2352 by 1568 pixels
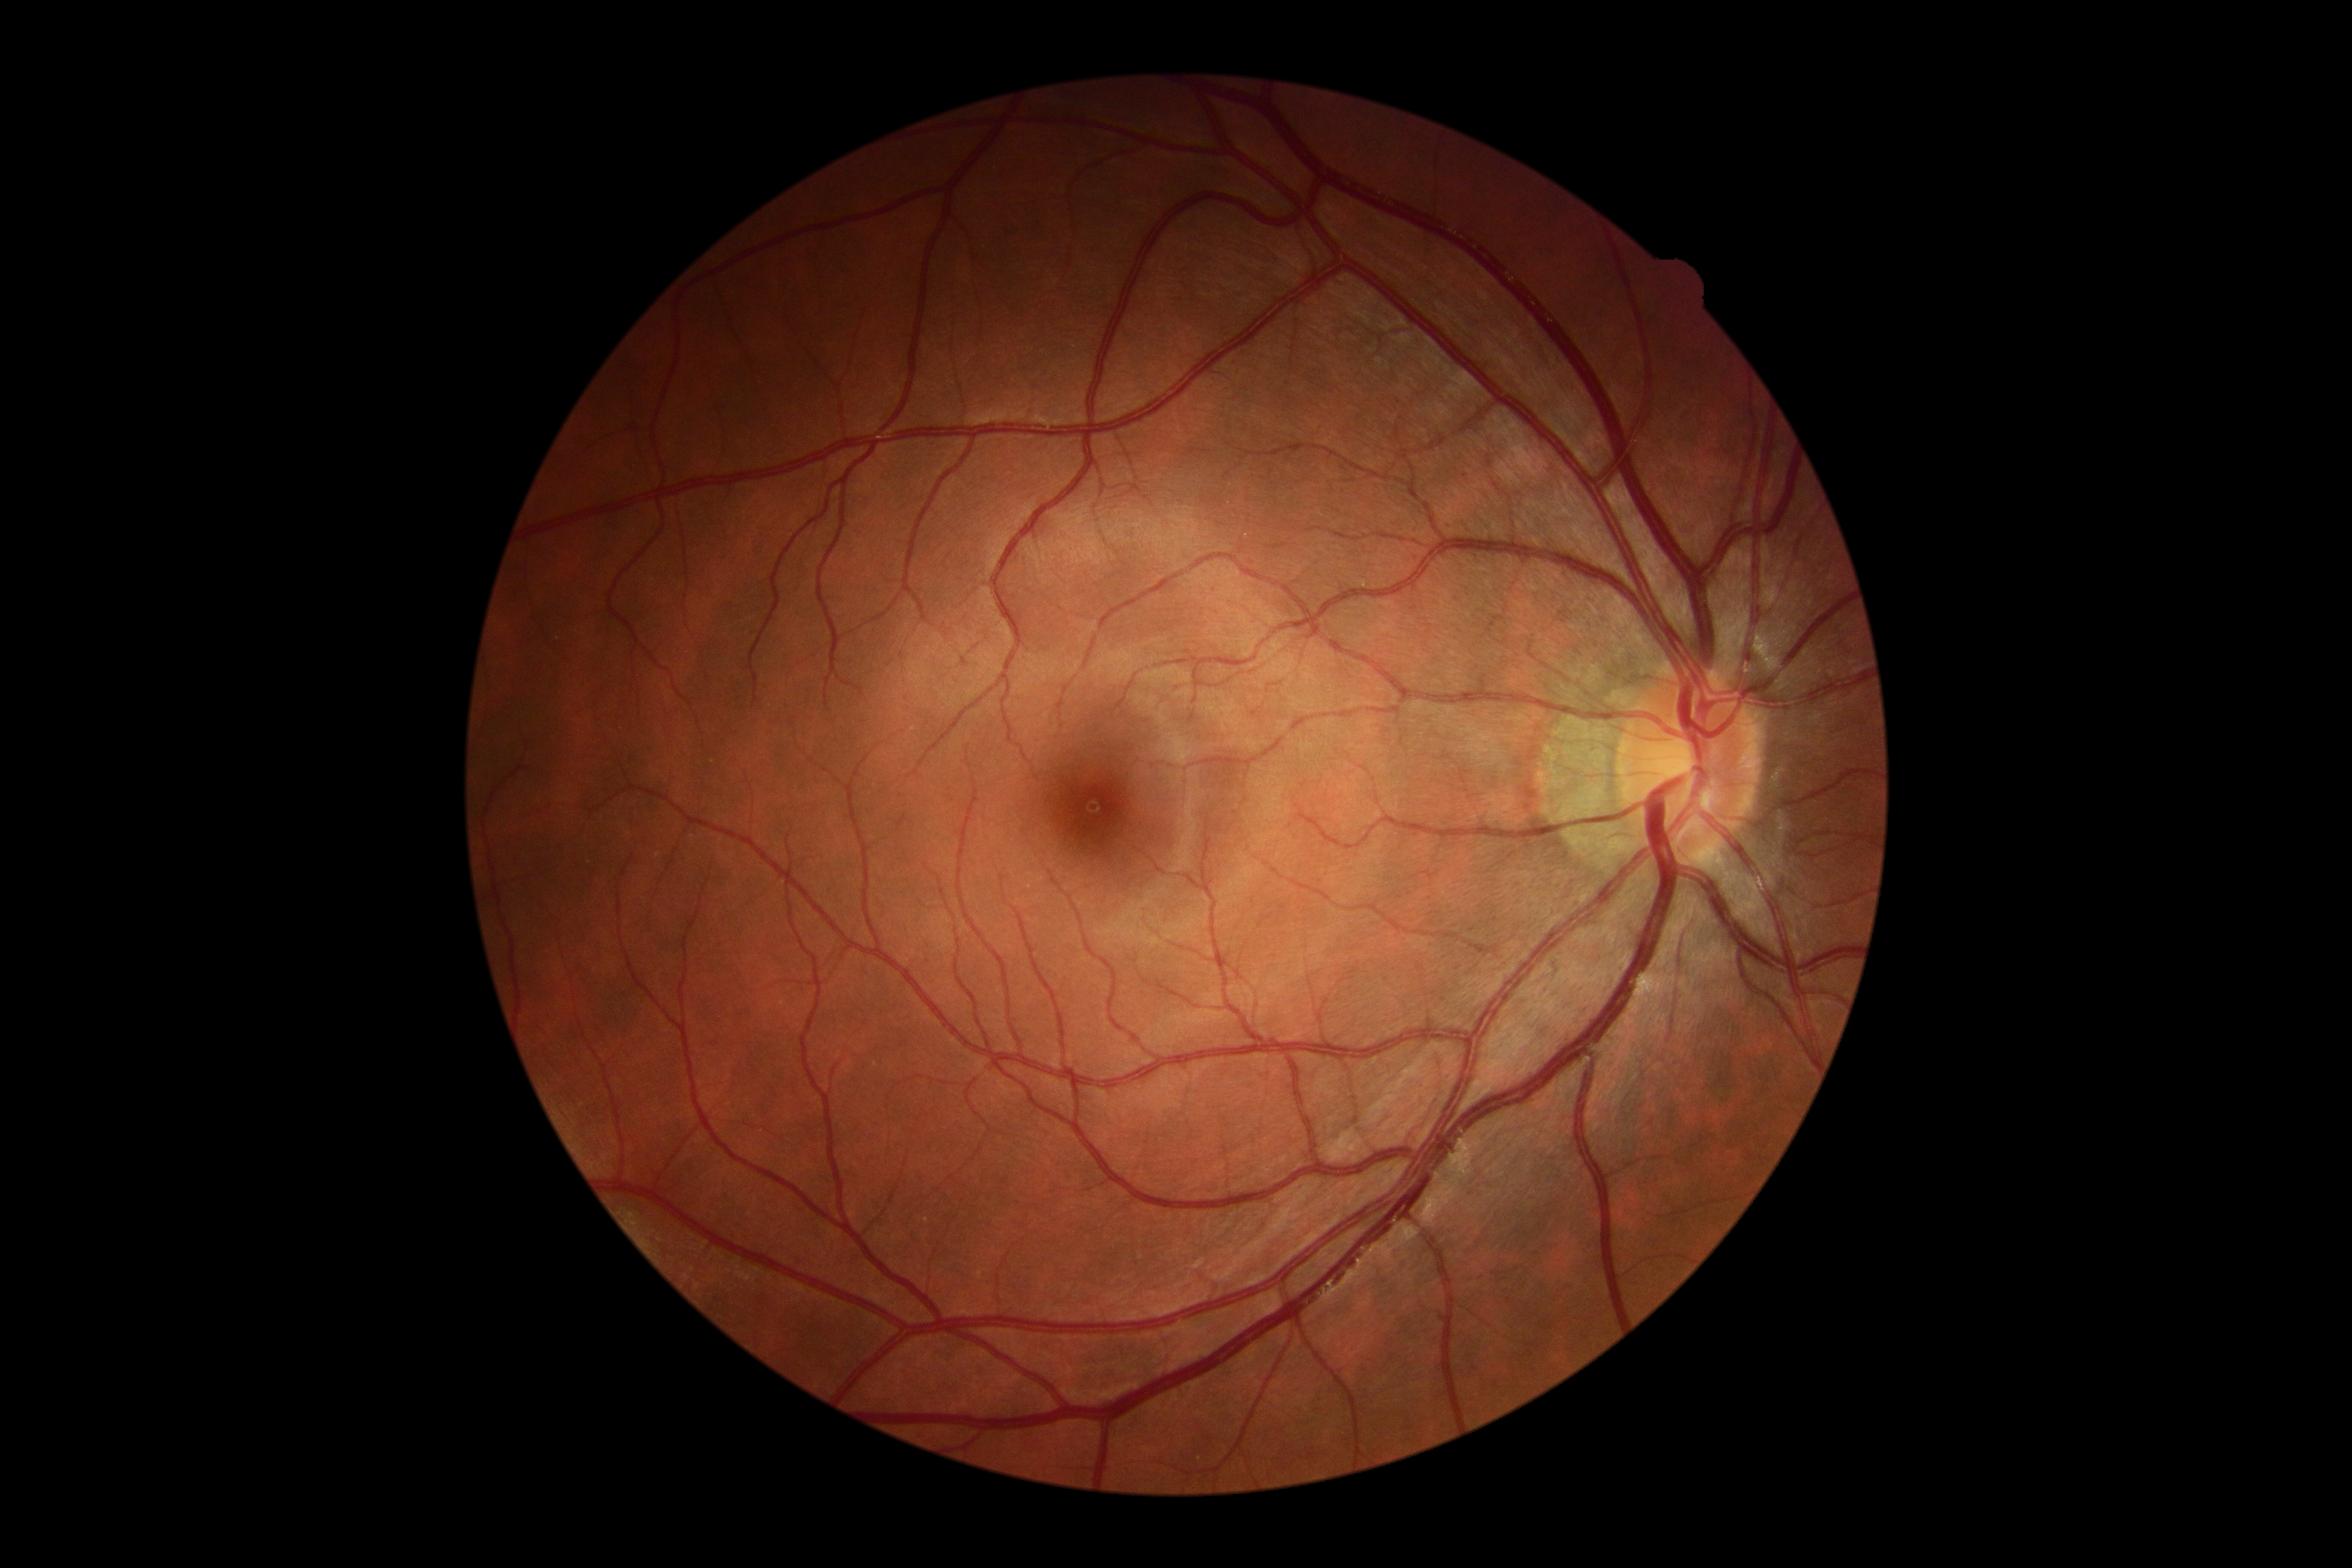 DR severity: no apparent diabetic retinopathy (grade 0).